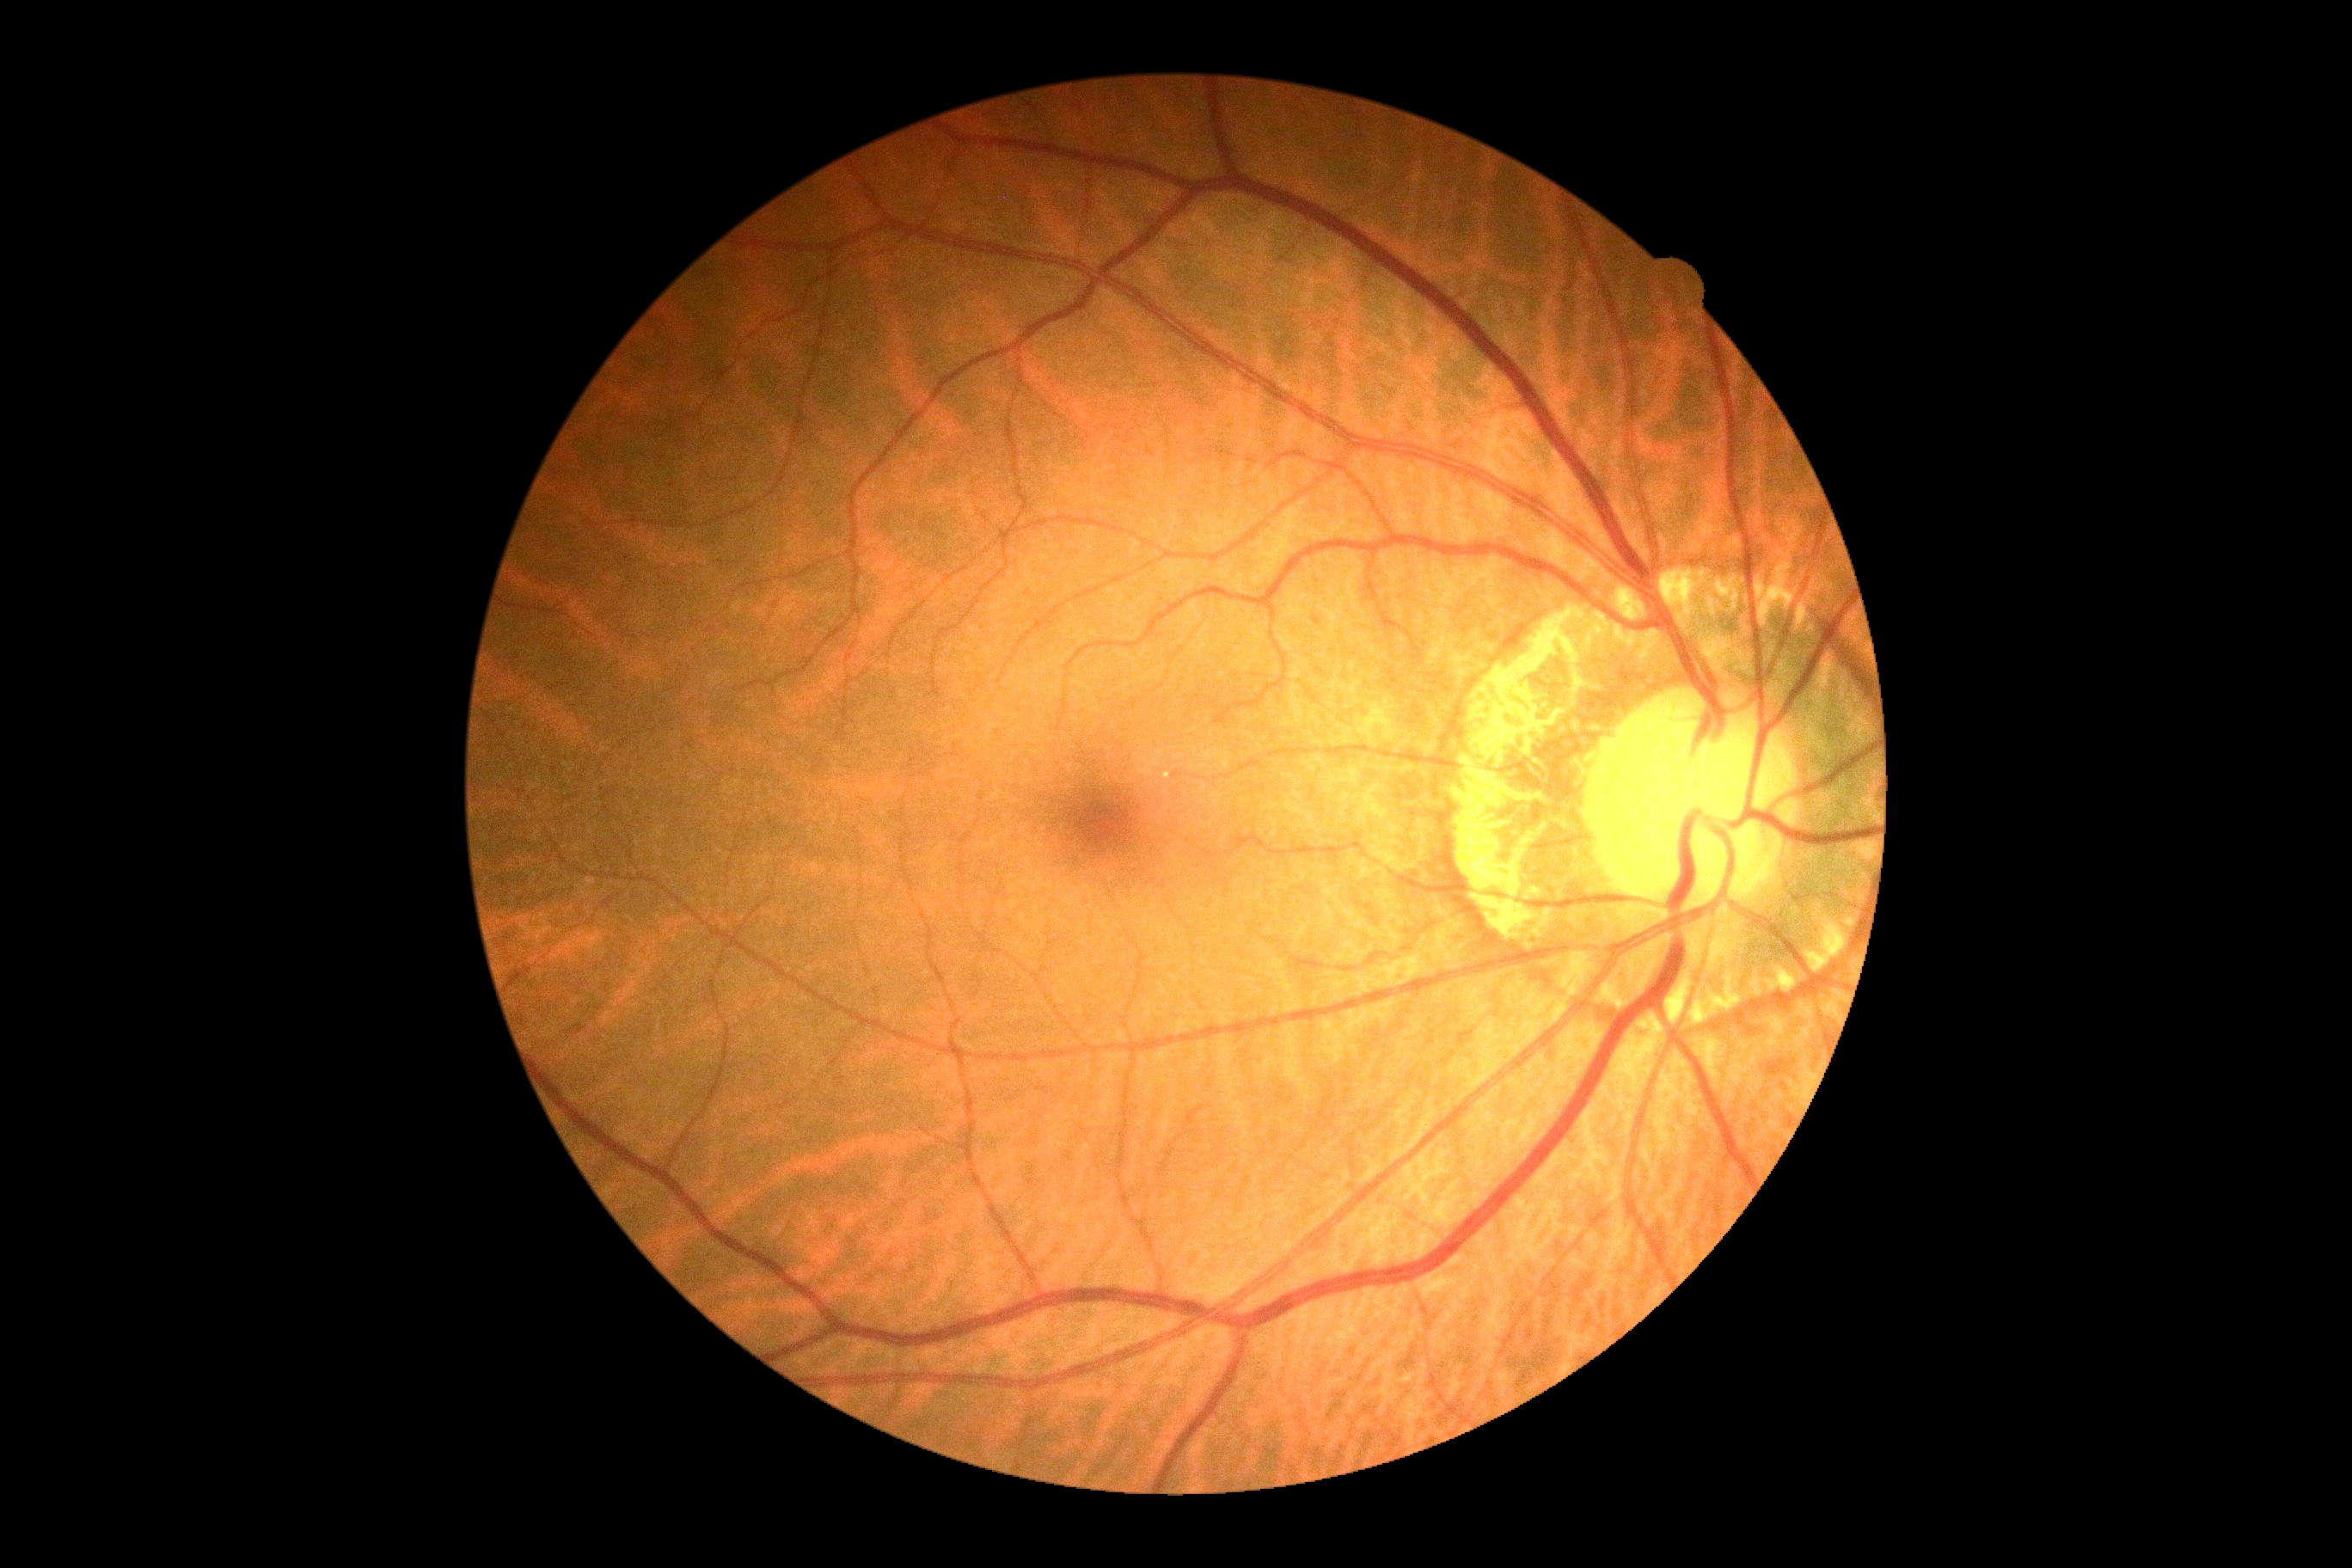

– DR impression — no signs of DR
– diabetic retinopathy — grade 0